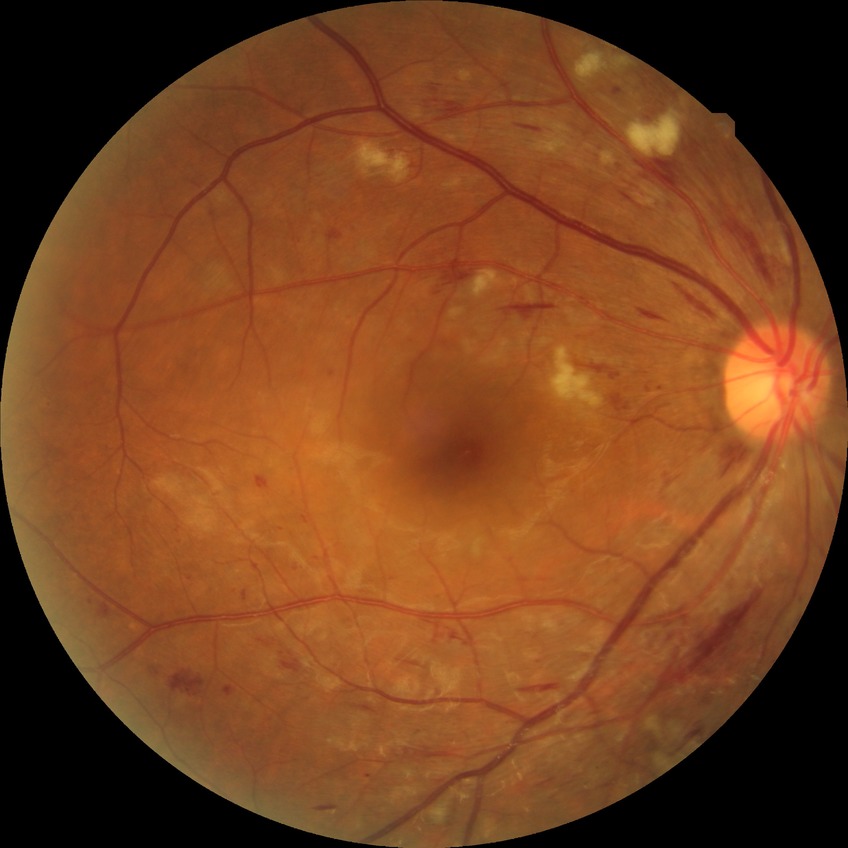
Diabetic retinopathy (DR): pre-proliferative diabetic retinopathy (PPDR).